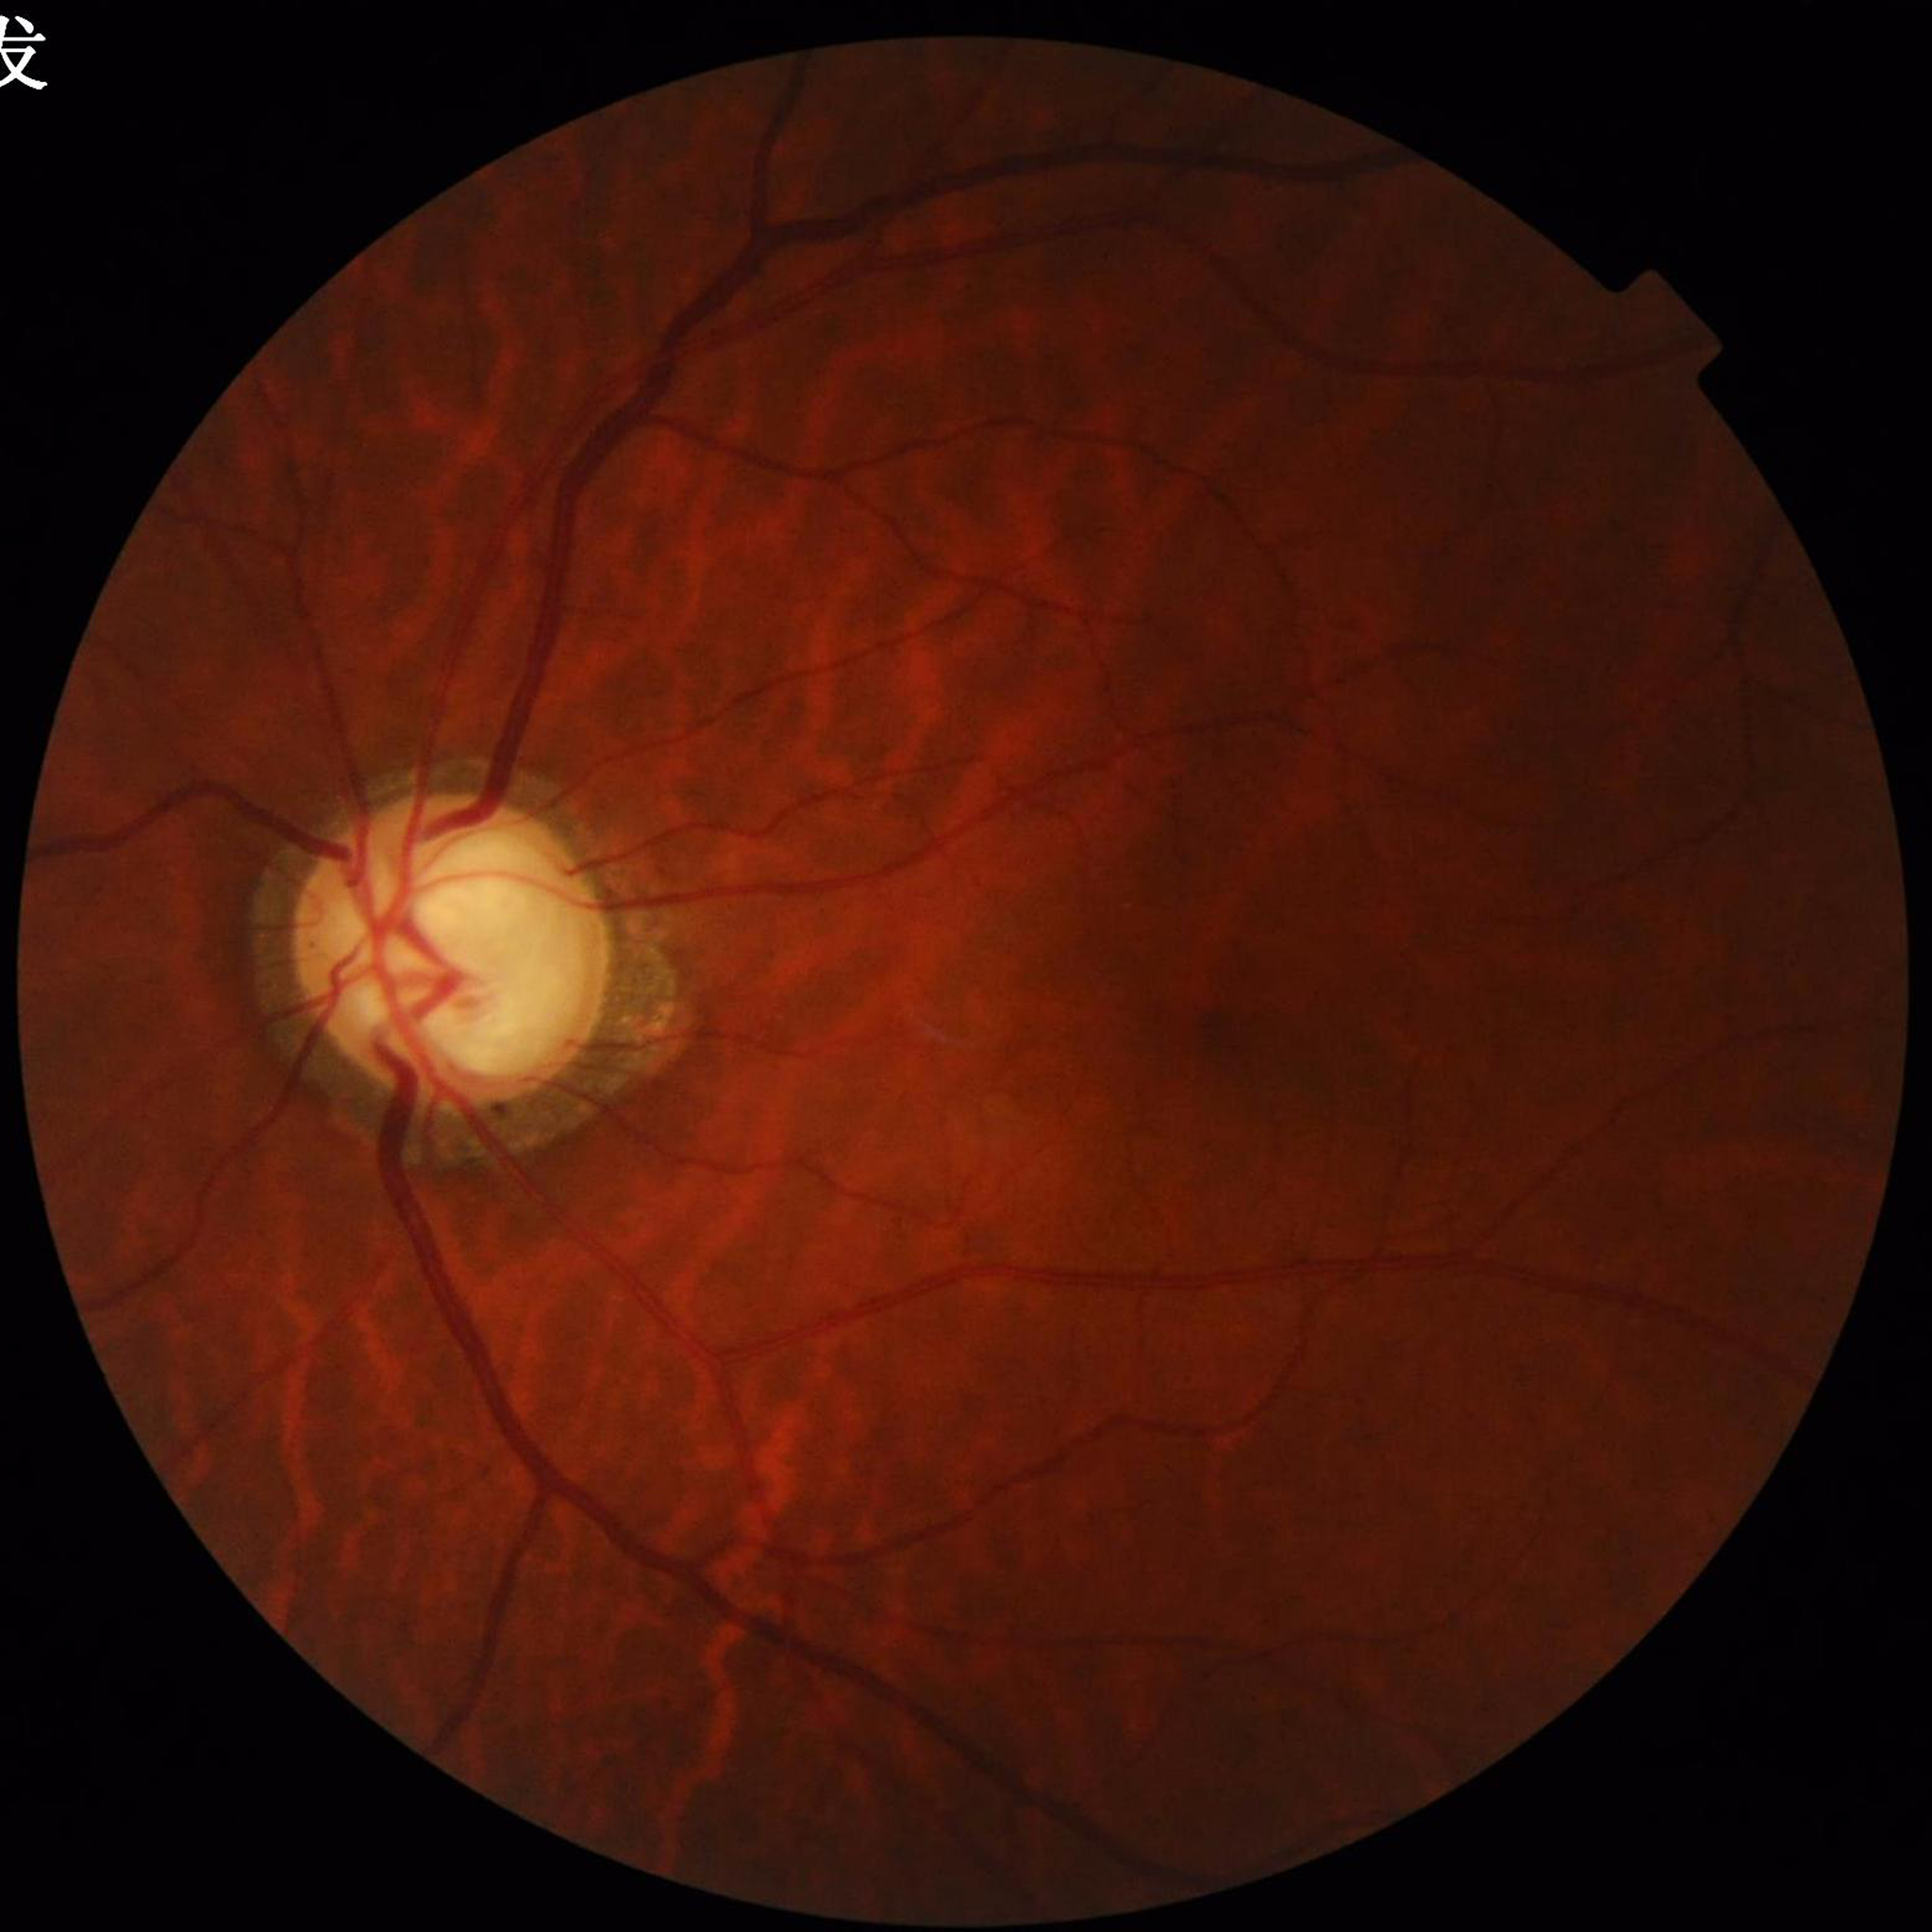

Photo quality: good
Diagnosis: glaucoma